CFP — 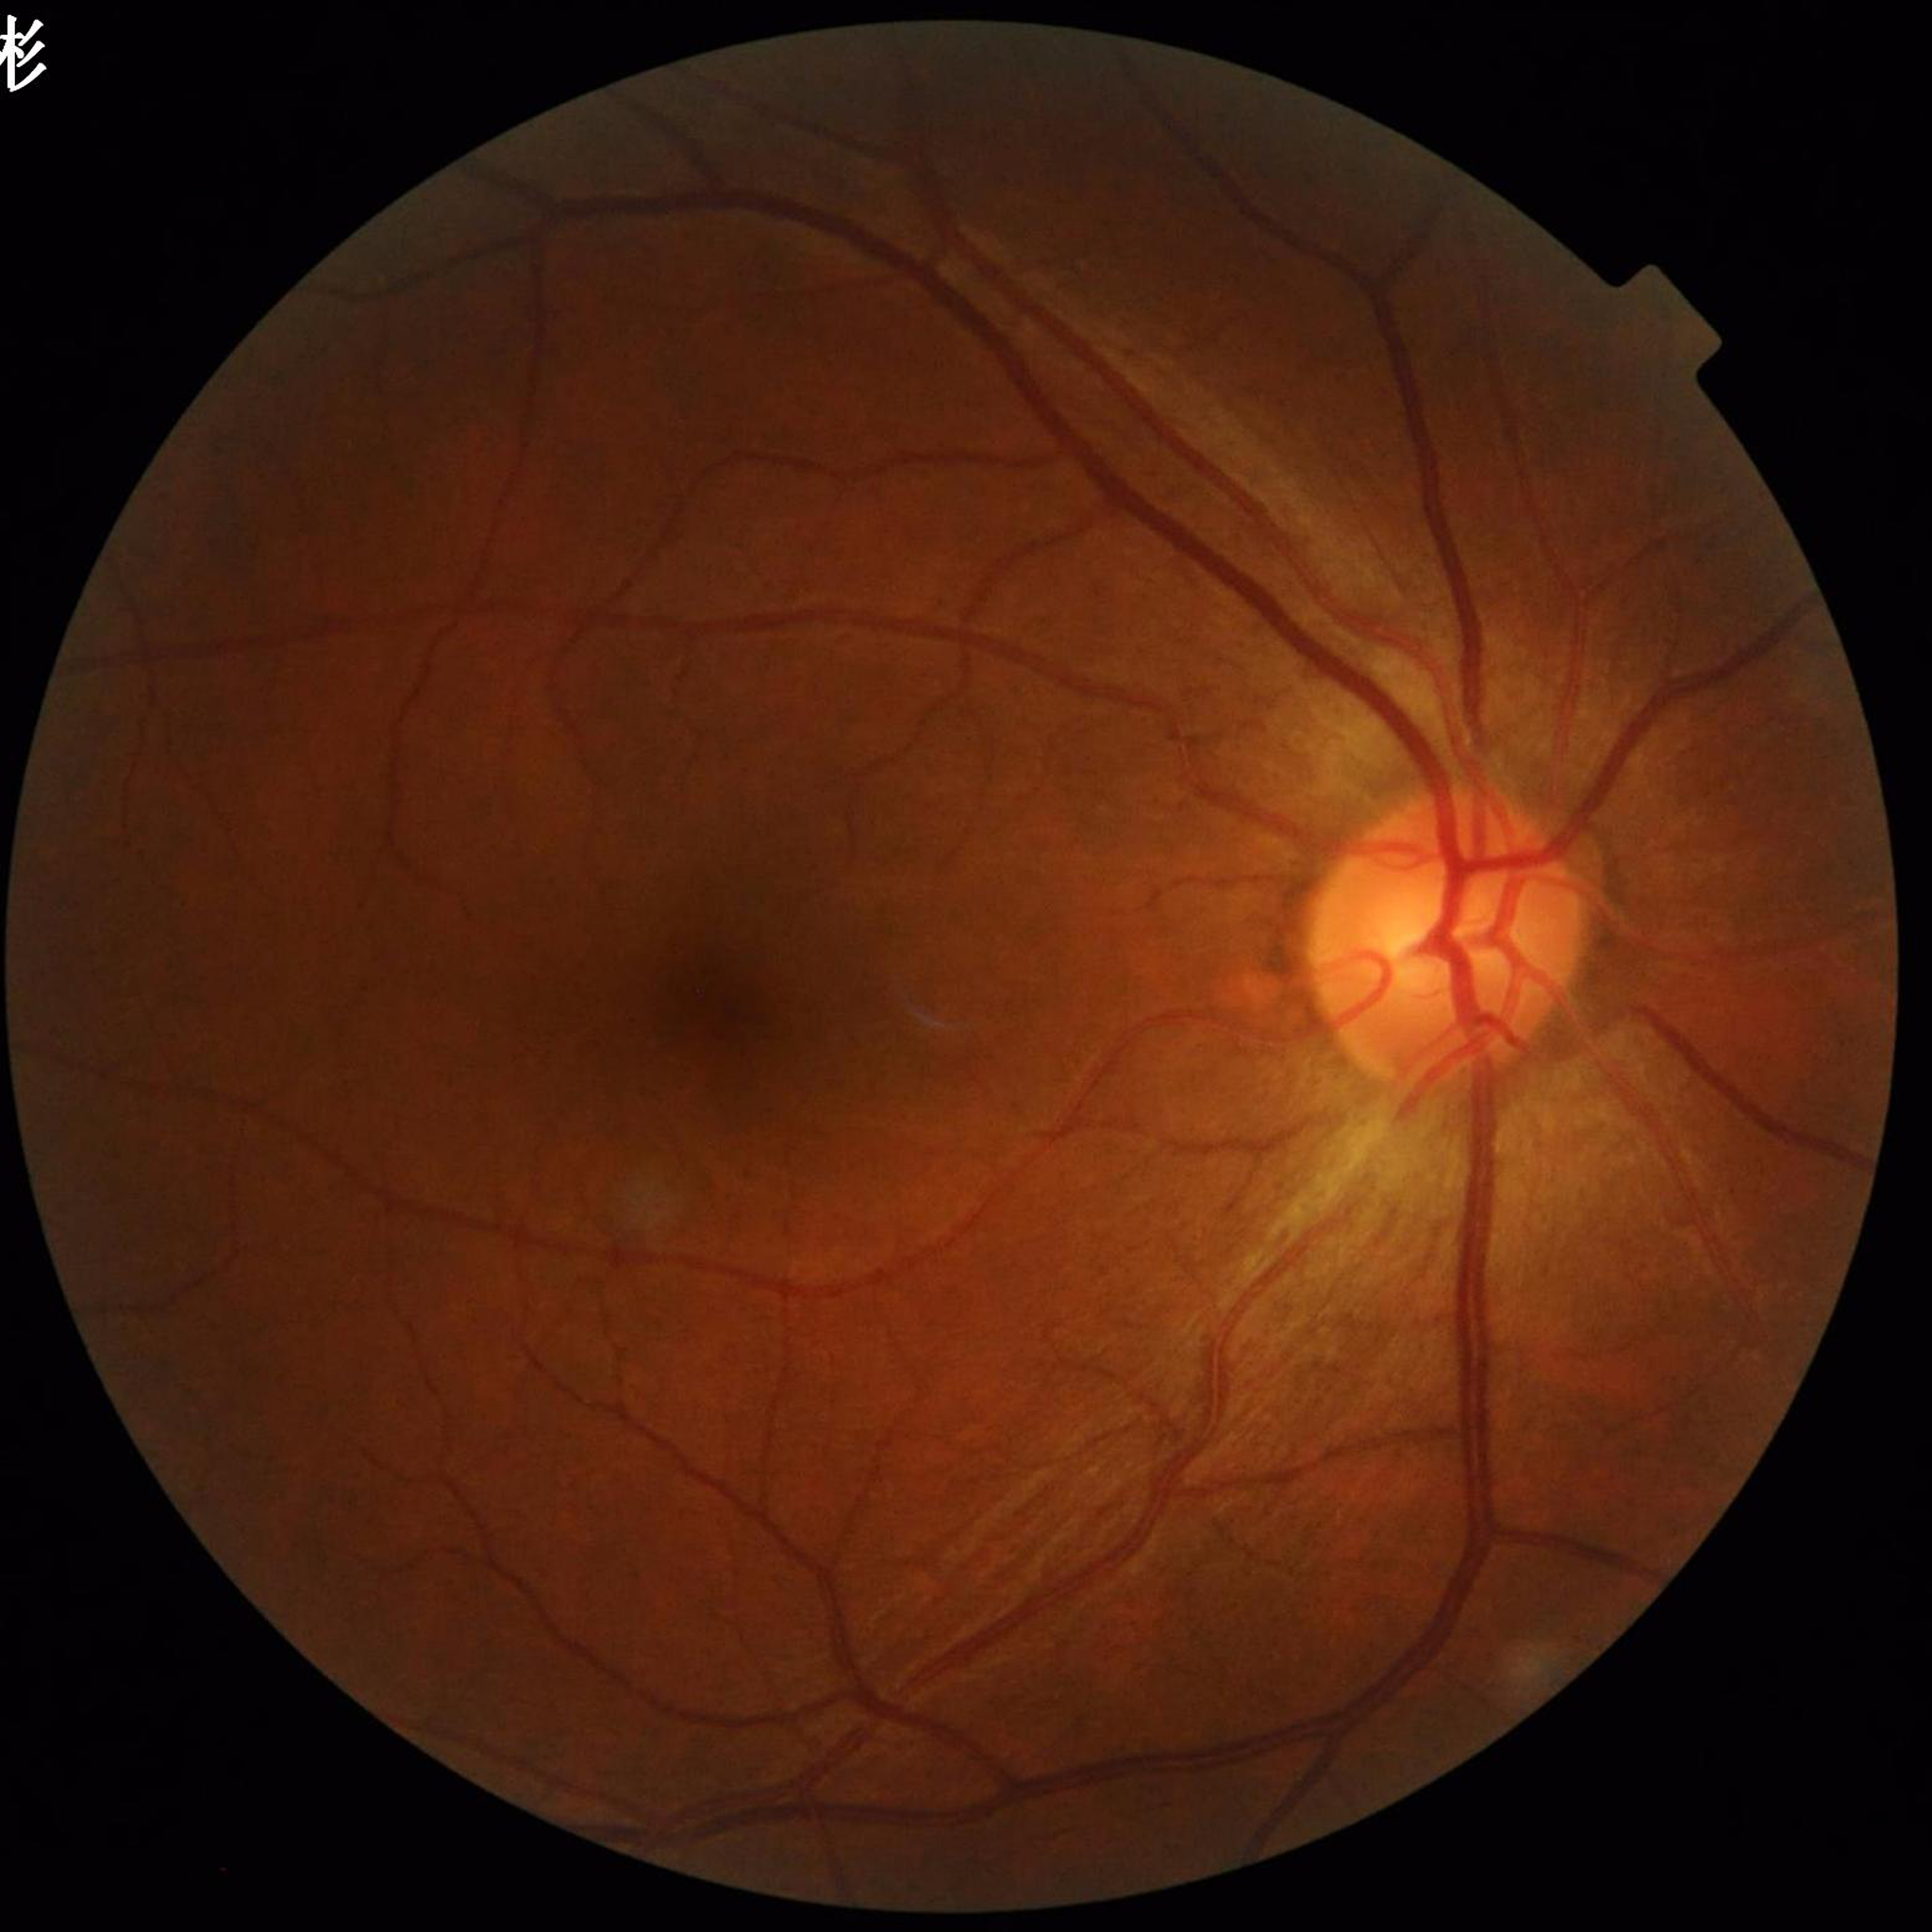

Disease class: glaucoma.